45° field of view. CFP. Image size 1932x1910.
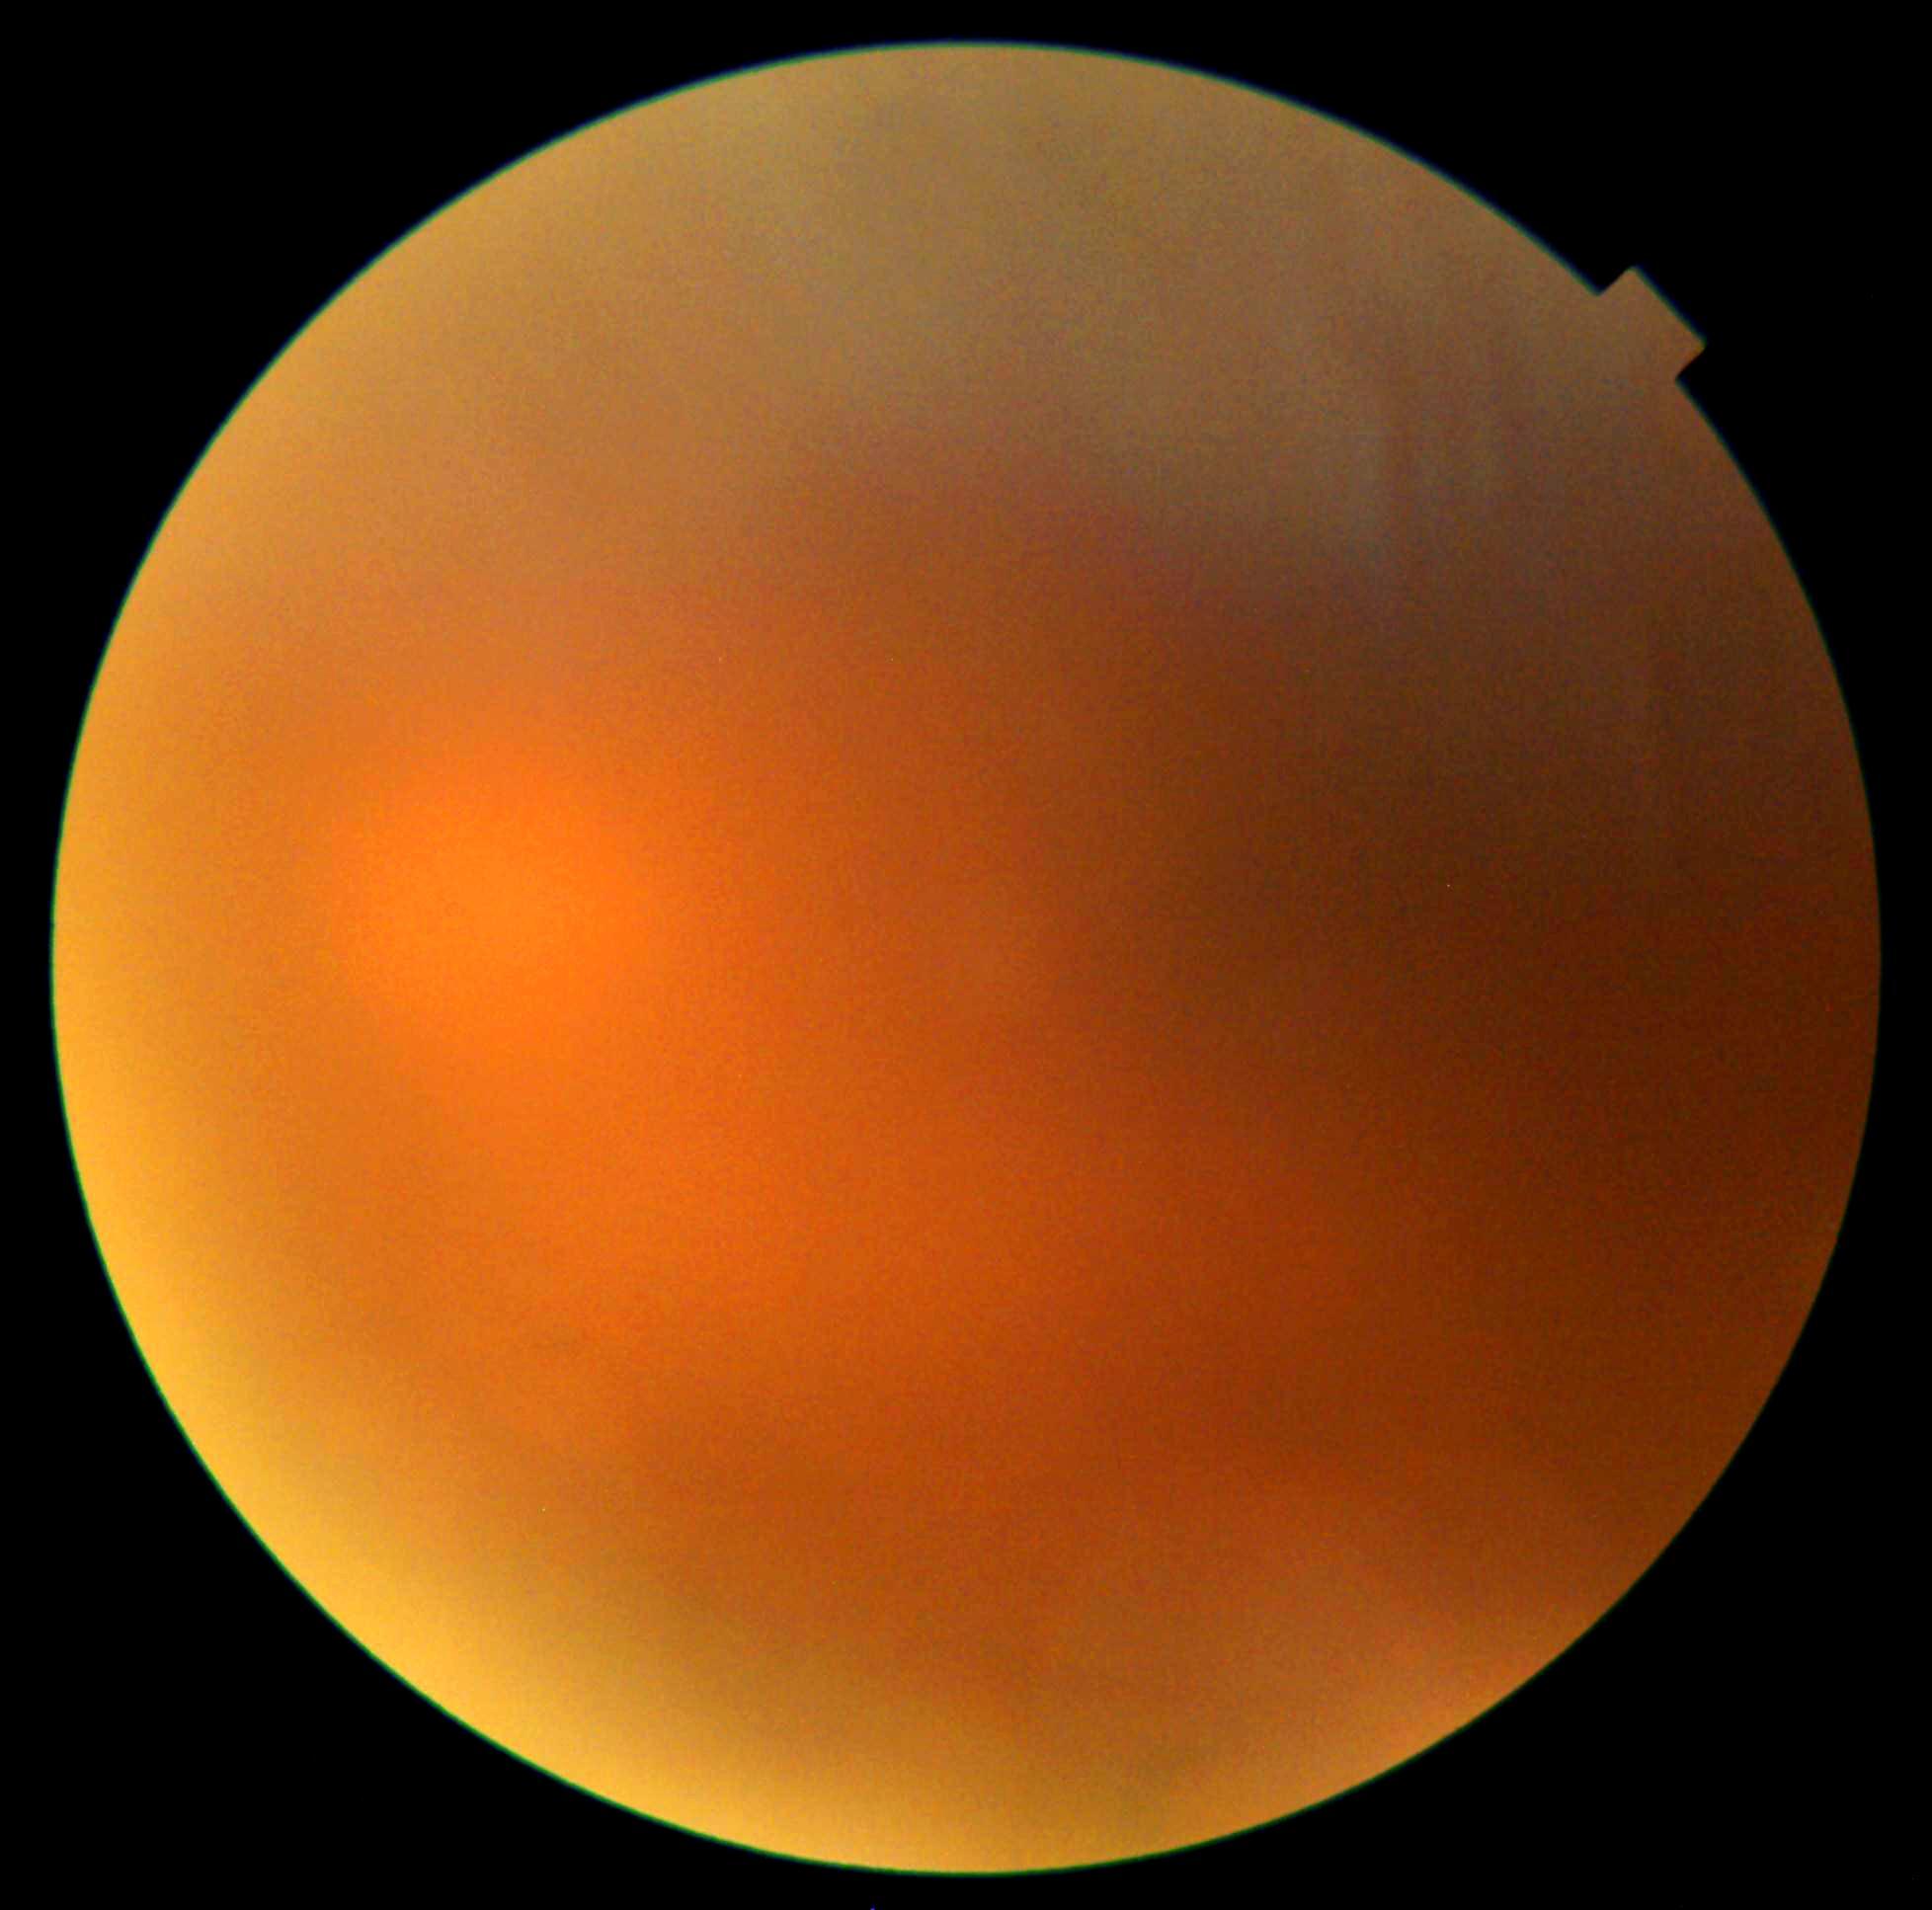
{"dr_grade": "ungradable"}